Diabetic retinopathy graded by the modified Davis classification — 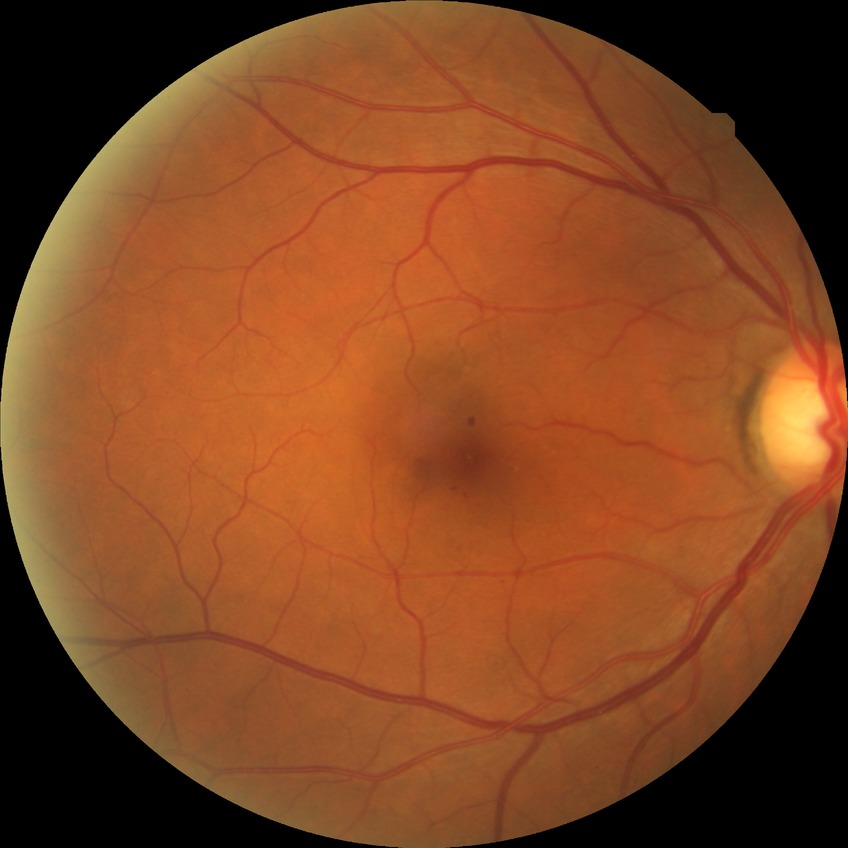 Diabetic retinopathy grade: simple diabetic retinopathy.